Central posterior field.
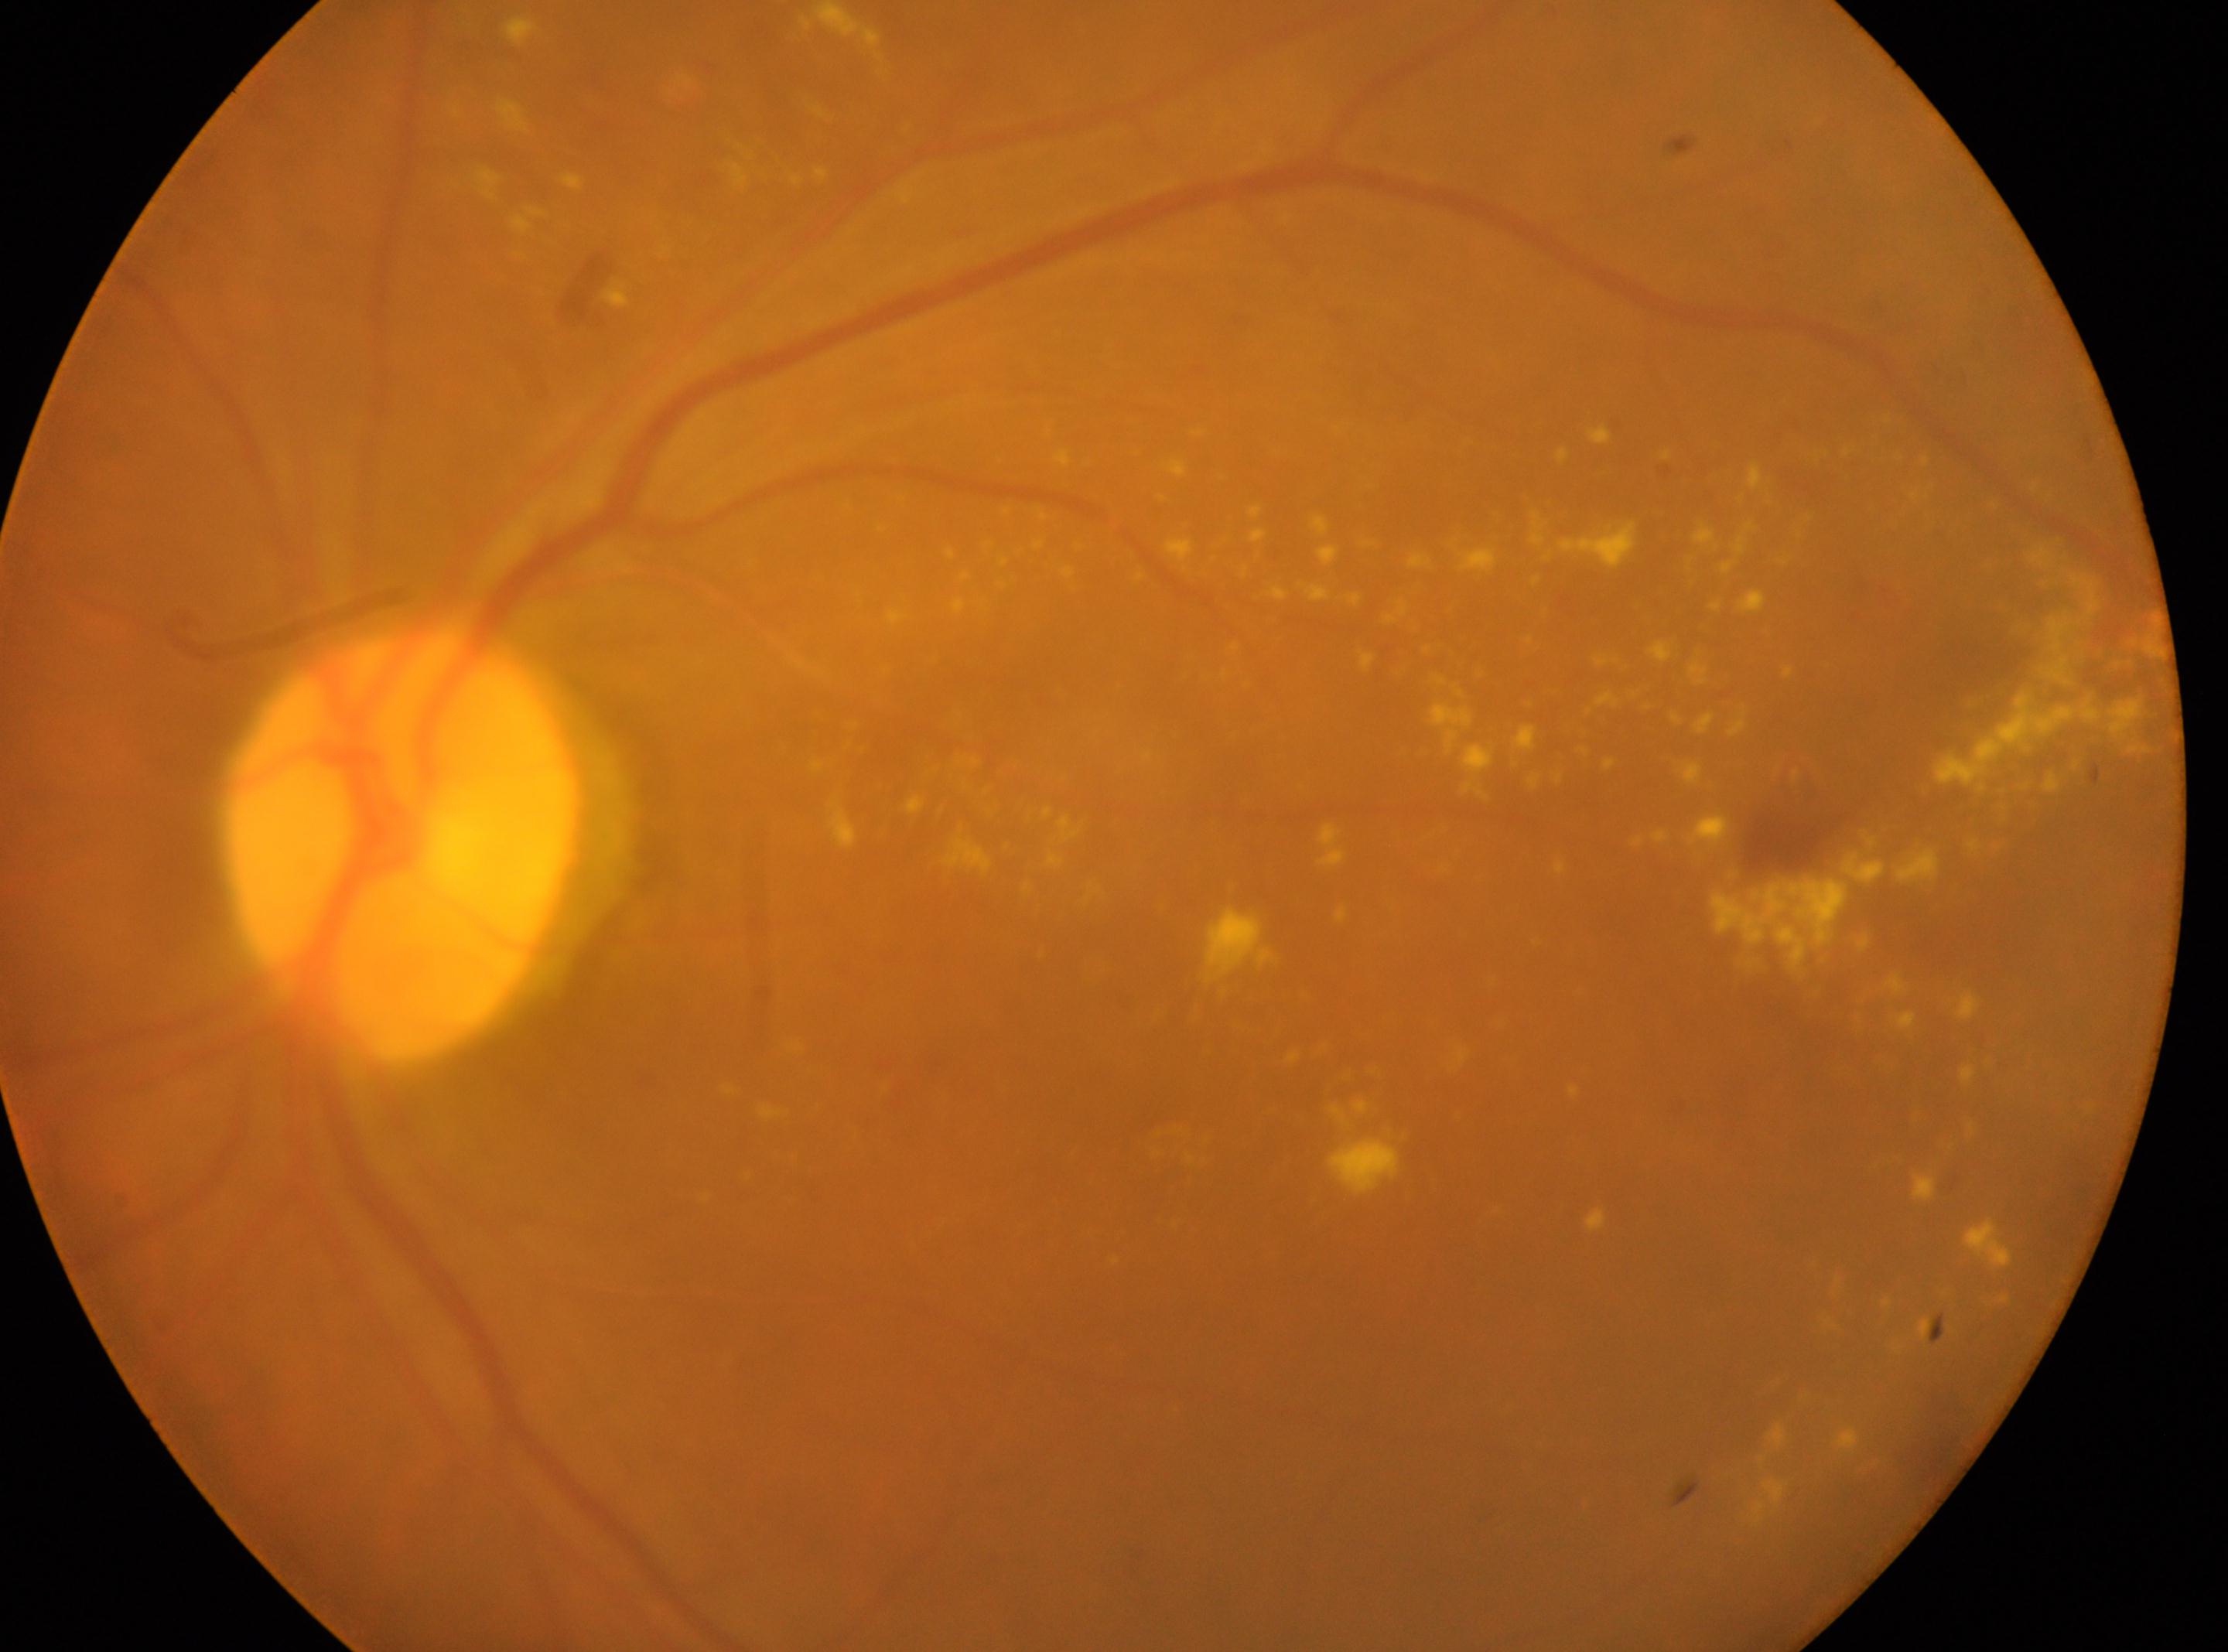

– optic disk · 402, 845
– eye · OS
– diabetic retinopathy (DR) · grade 2 (moderate NPDR)
– fovea centralis · 1227, 1067